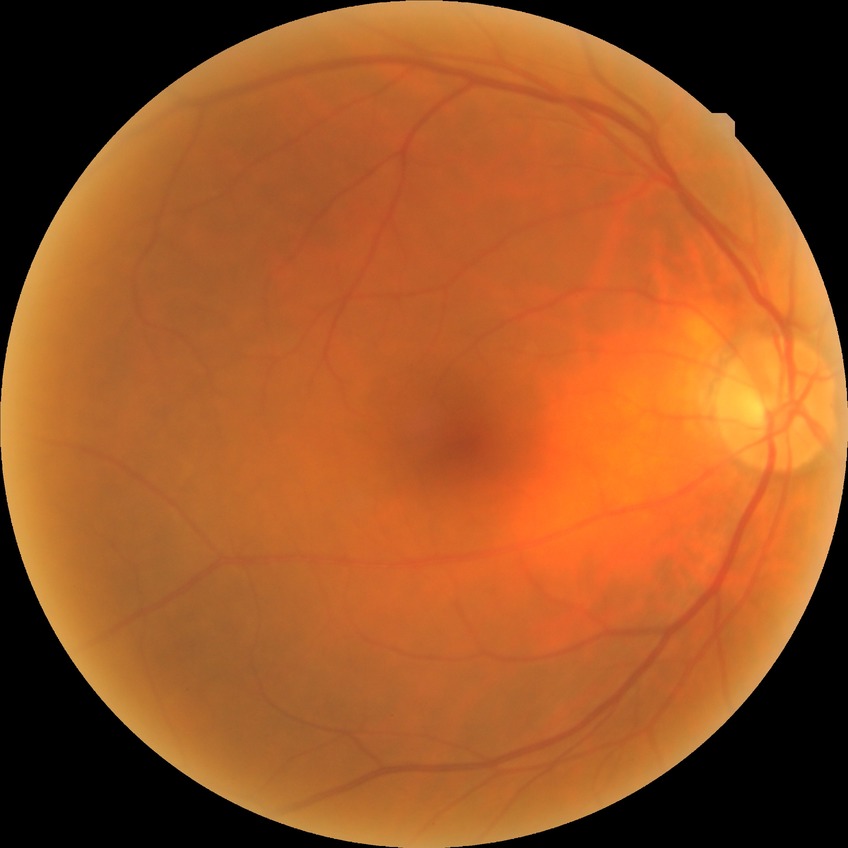

Diabetic retinopathy (DR) is no diabetic retinopathy (NDR).